512x512 — 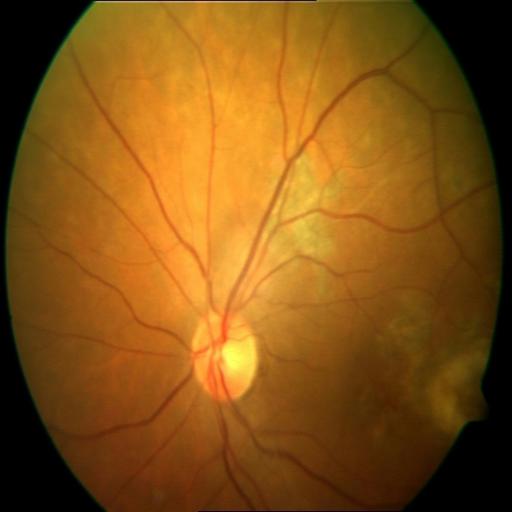

There is evidence of macular scar (MS).